Dilated-pupil acquisition: 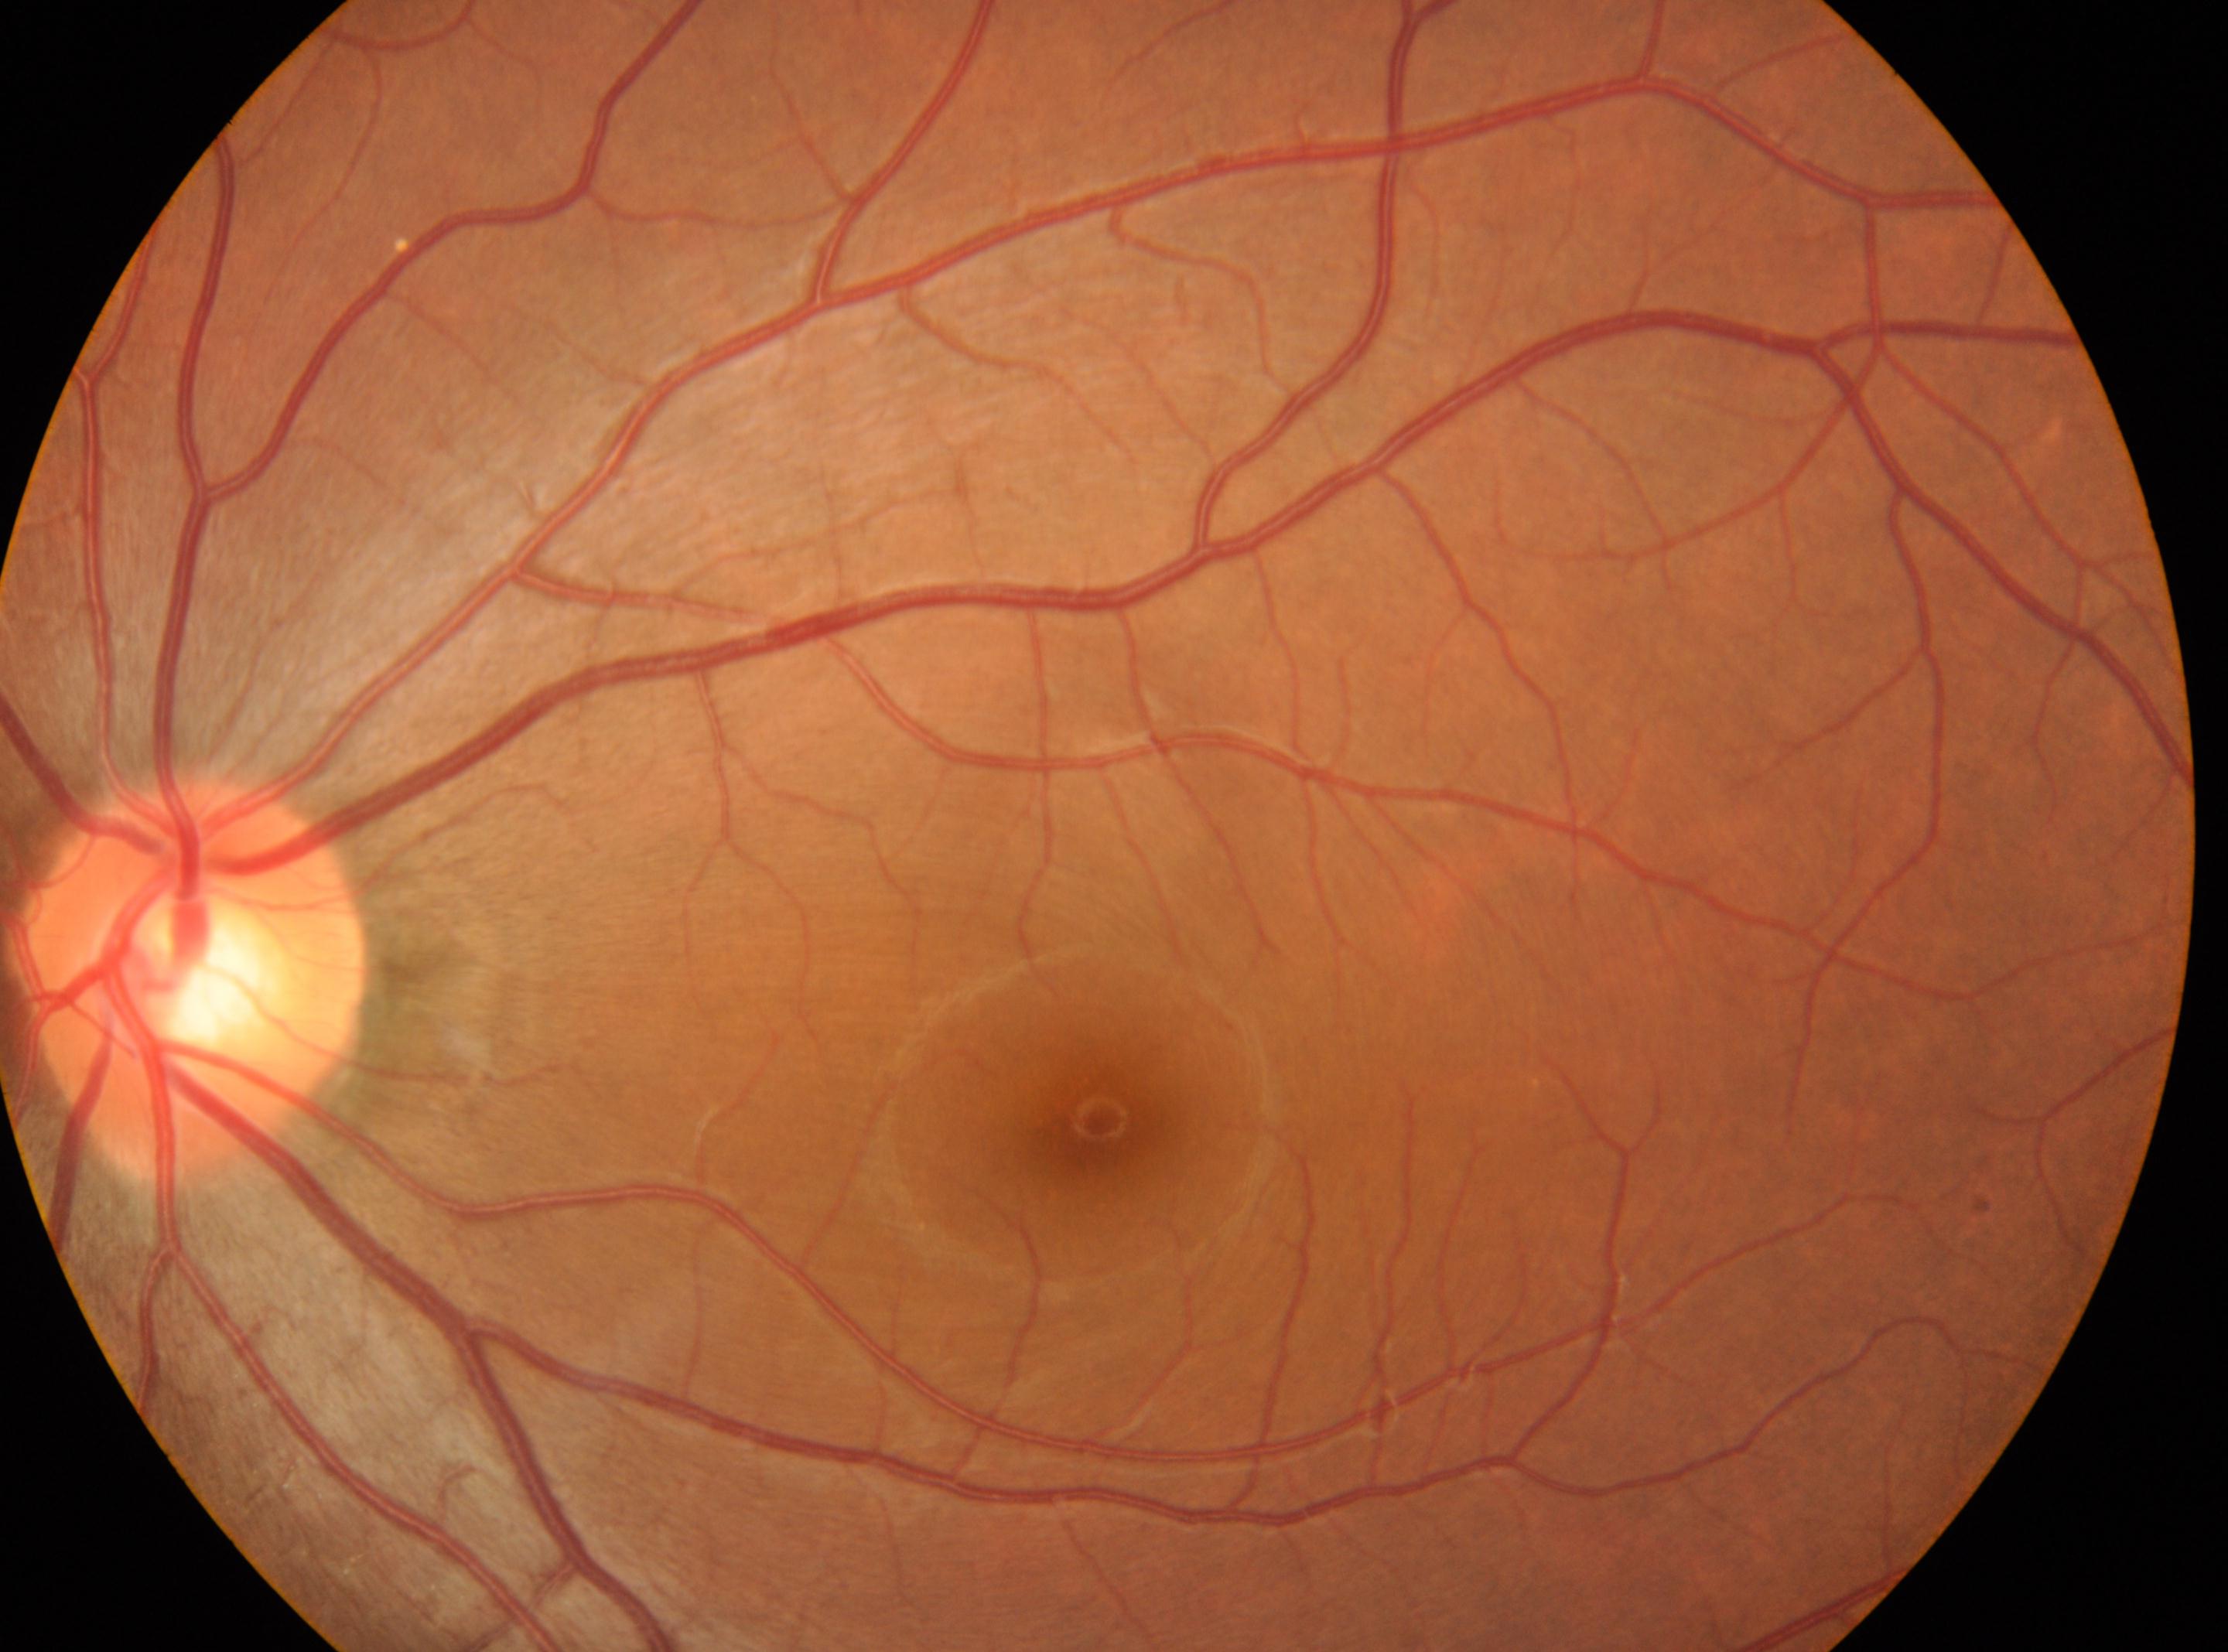 eye: OS | optic disc: 193px, 980px | foveal center: 1097px, 1125px | DR: no apparent retinopathy (grade 0).